Retinal fundus photograph · FOV: 50 degrees:
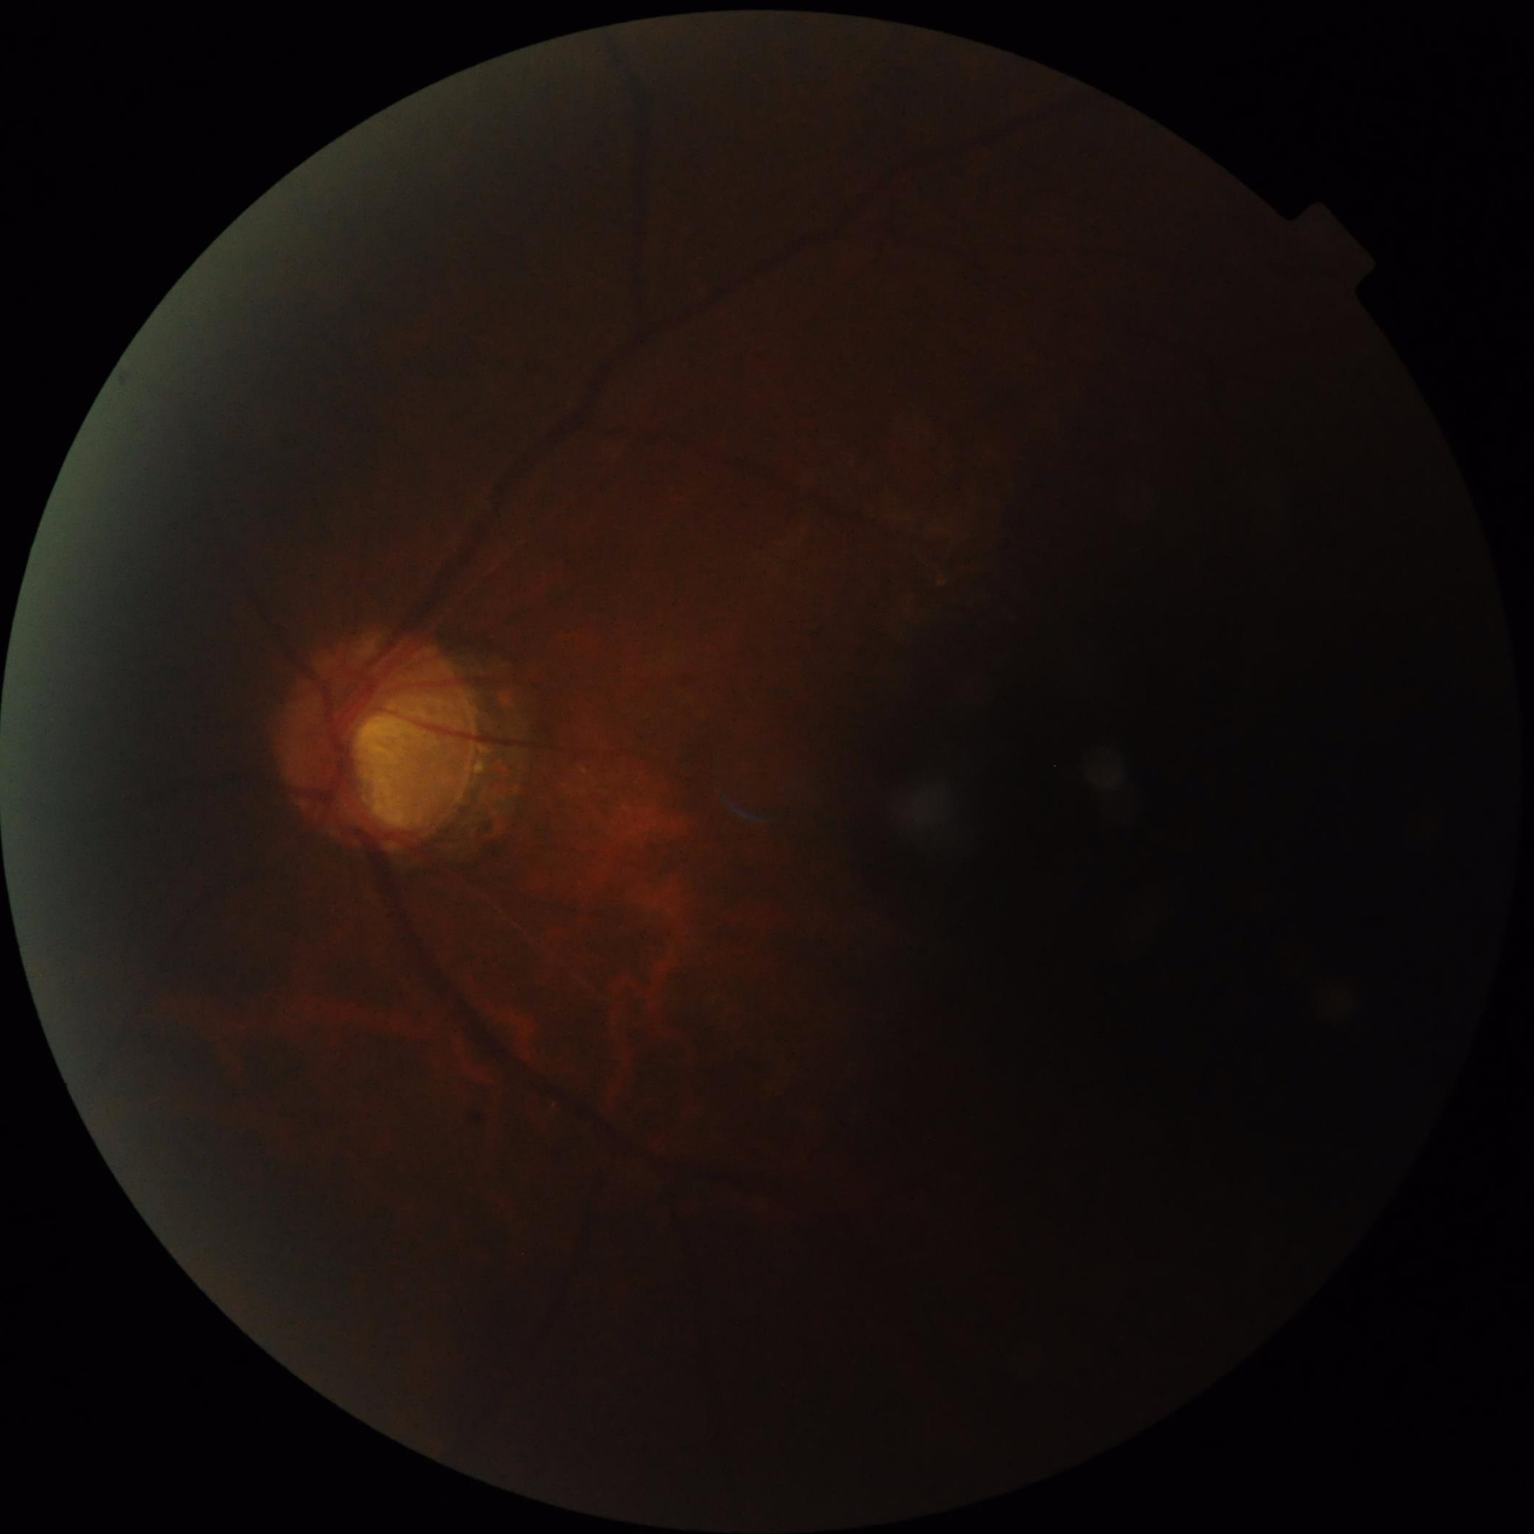

Quality grading: illumination/color: inadequate, with uneven exposure or color distortion; sharpness: out of focus, structures indistinct; overall: inadequate for clinical interpretation; contrast: low, vessels and details hard to distinguish.